CFP, 45° FOV:
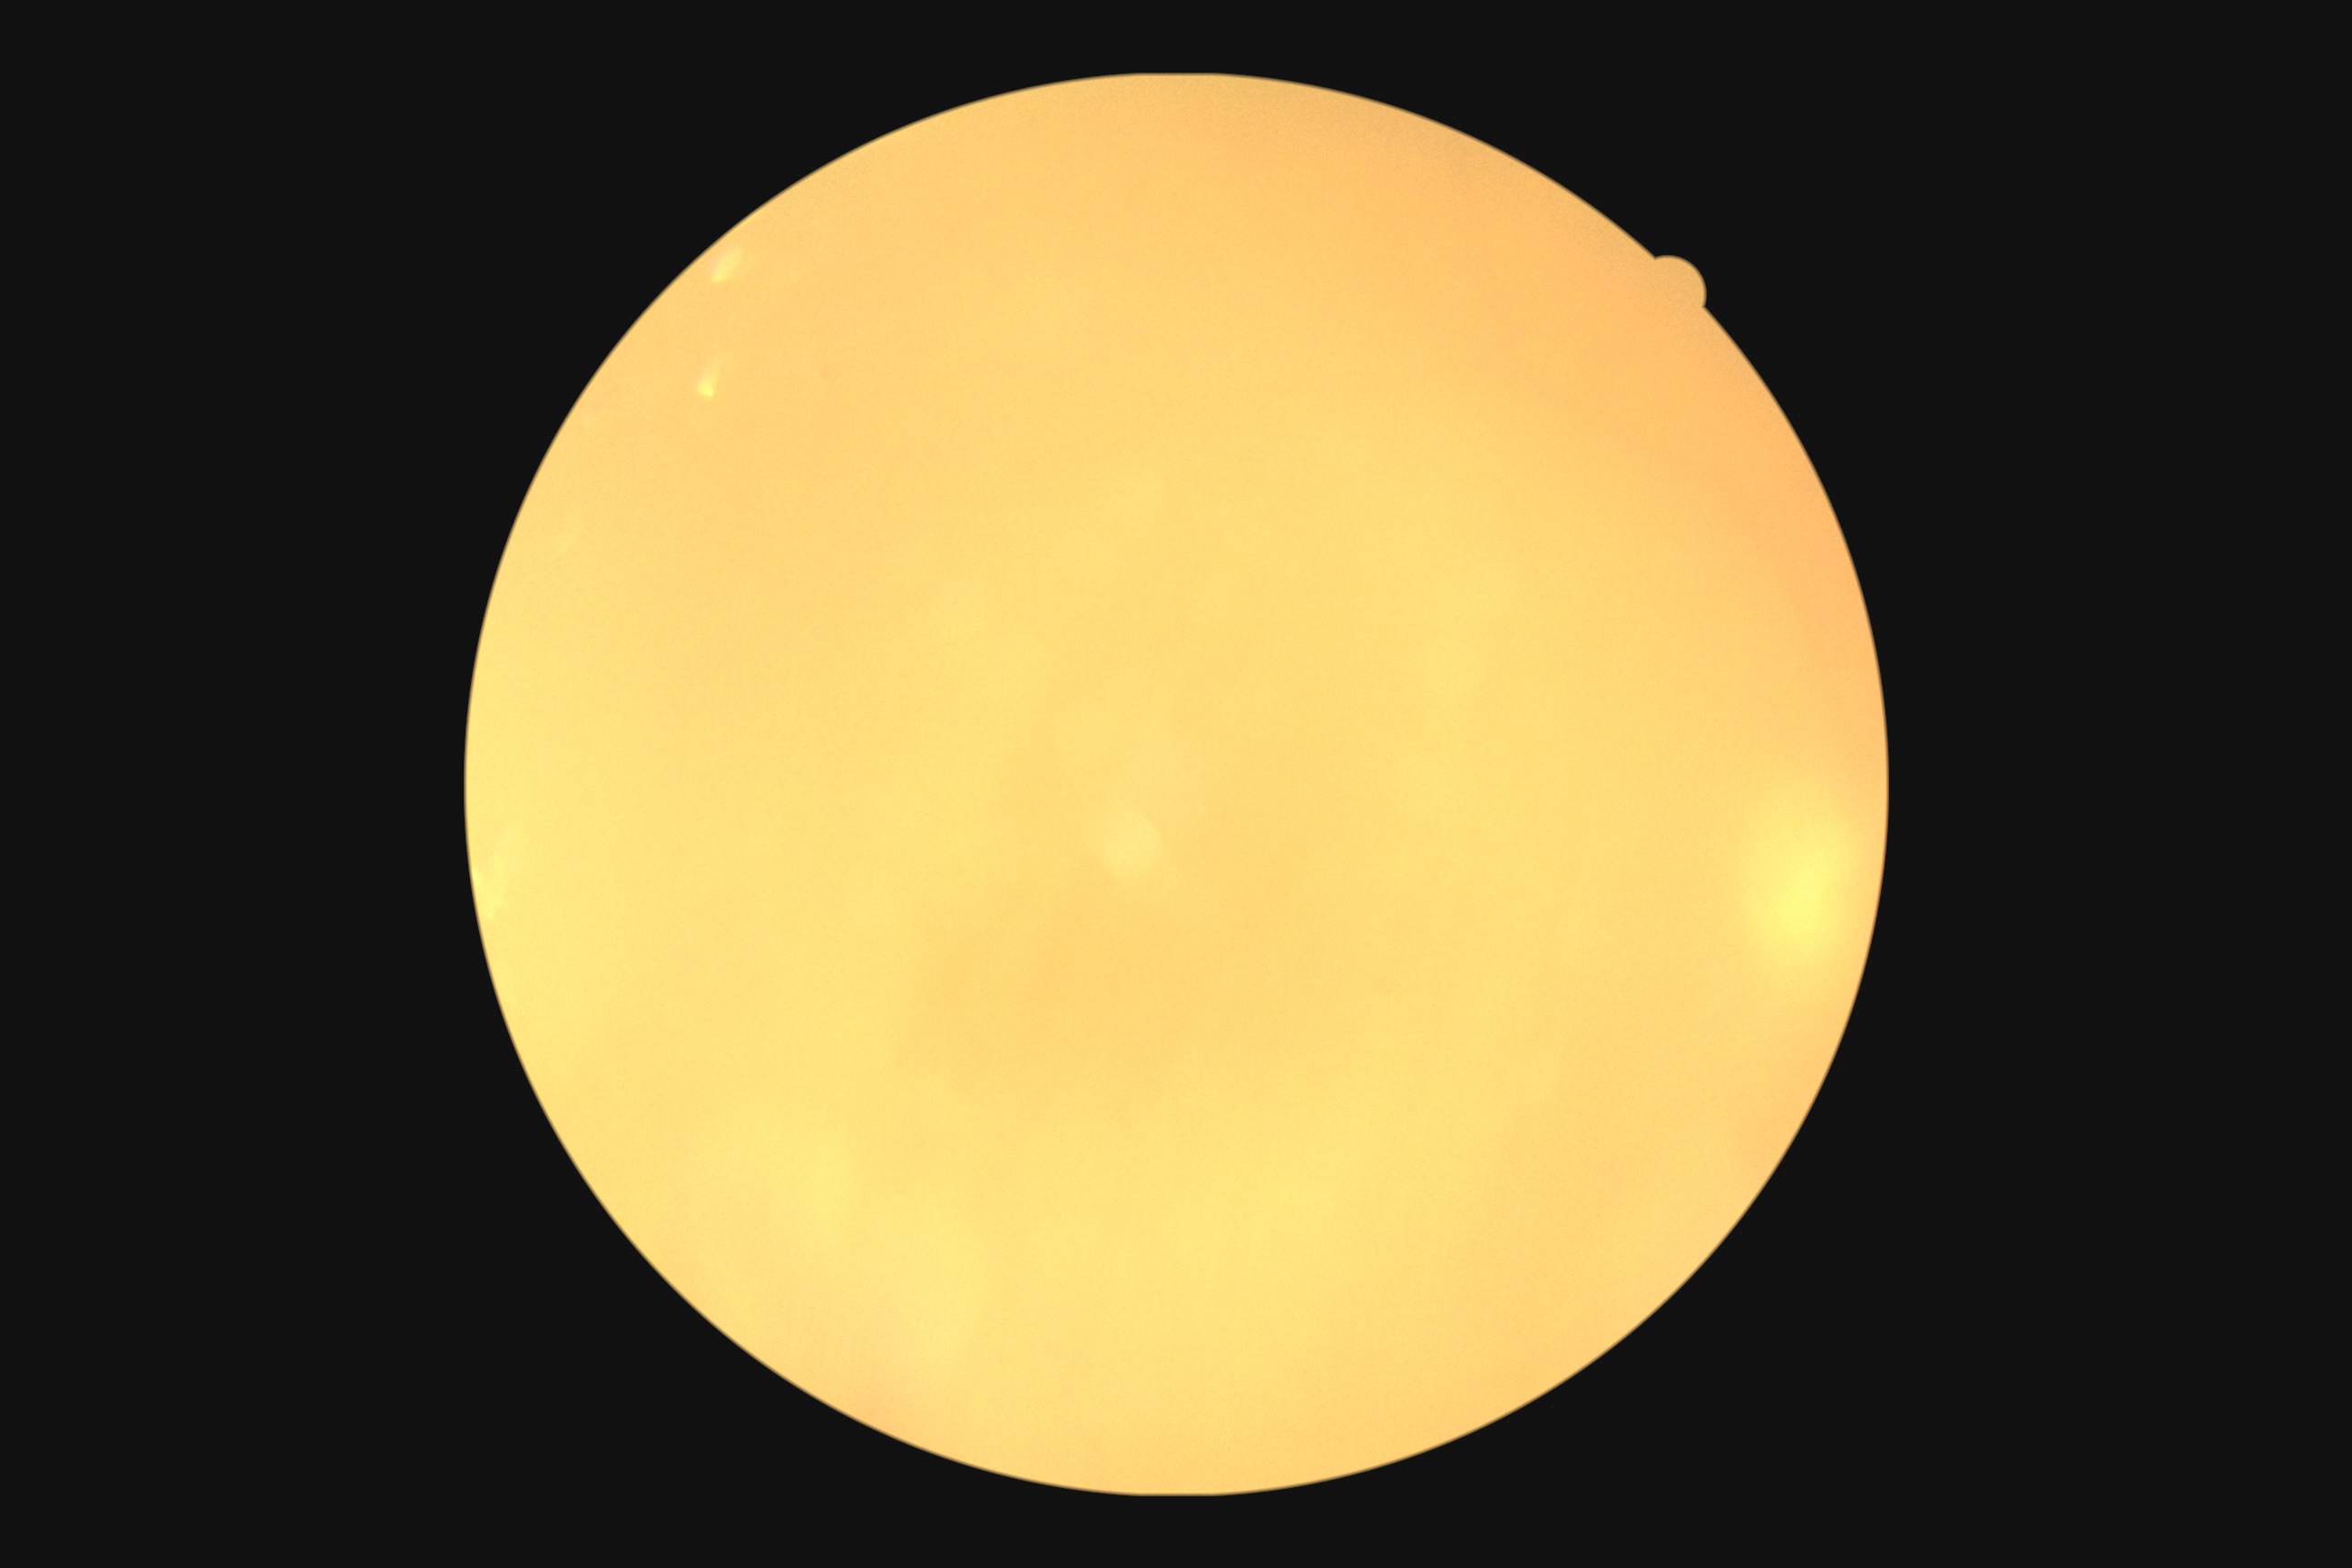 Quality too poor to assess for DR. DR: ungradable.